Color fundus photograph.
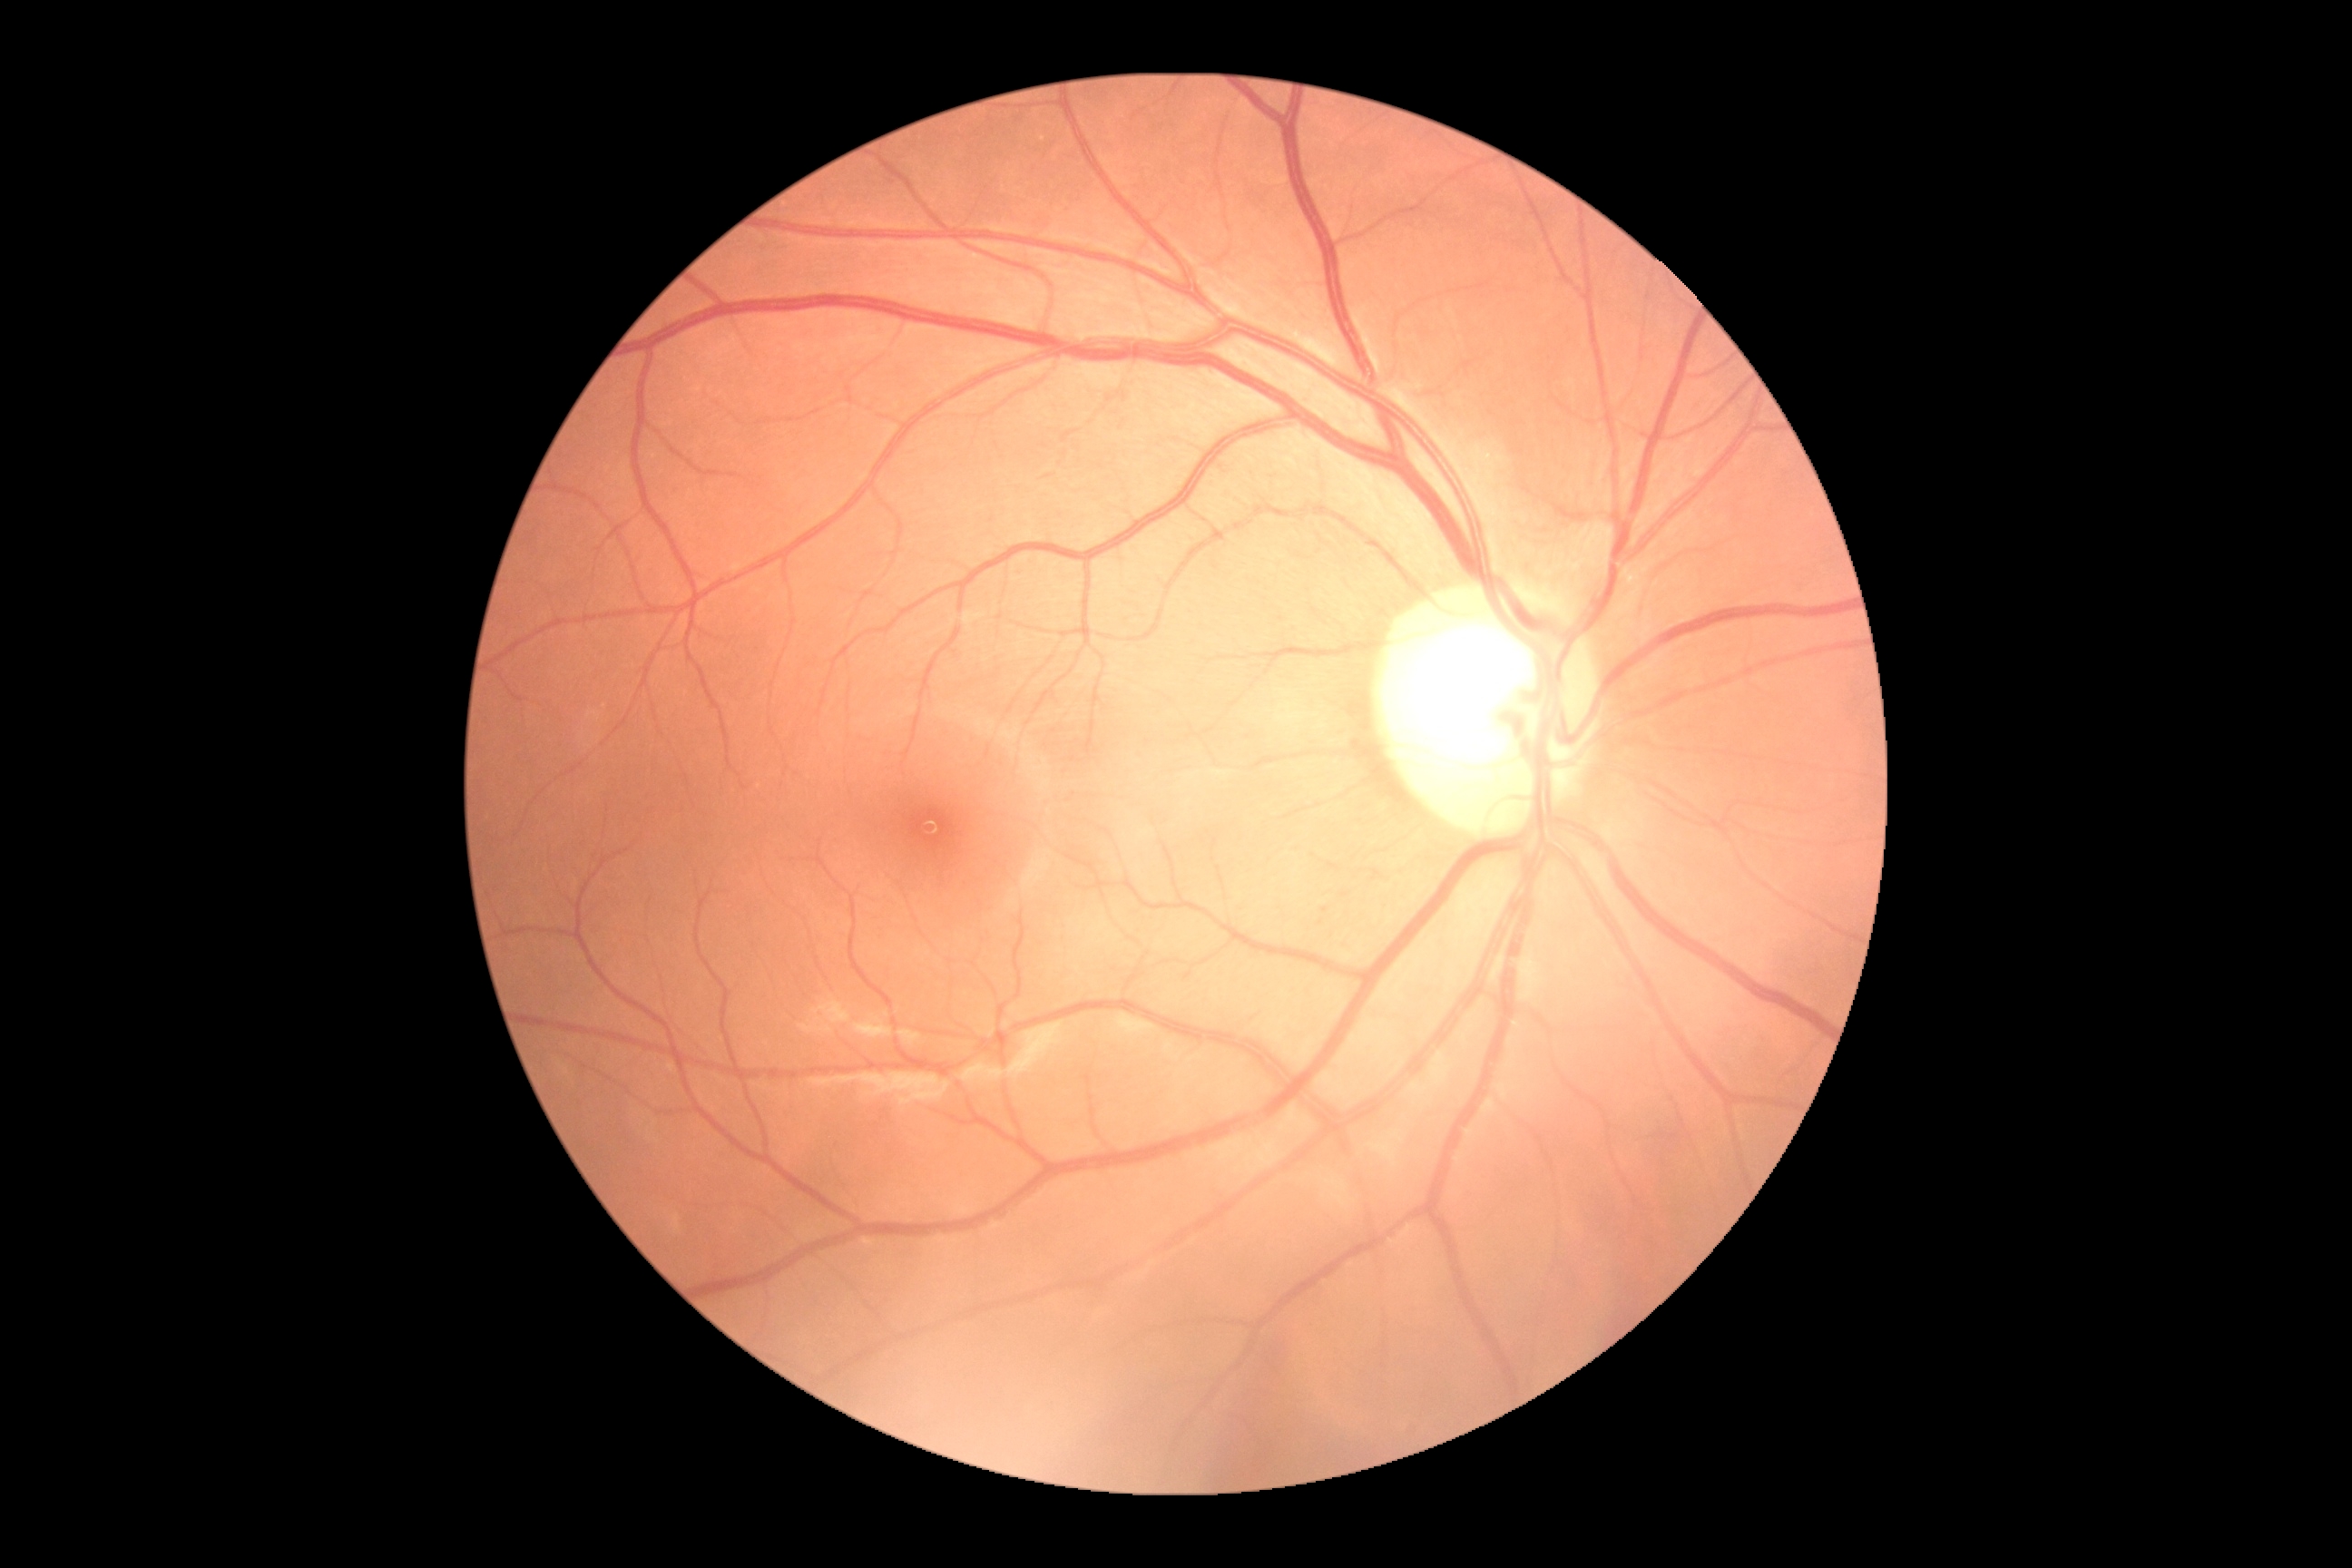 Findings:
- DR stage — no apparent retinopathy (grade 0)
- DR impression — no signs of DR